Posterior pole photograph · 848 x 848 pixels · 45 degree fundus photograph — 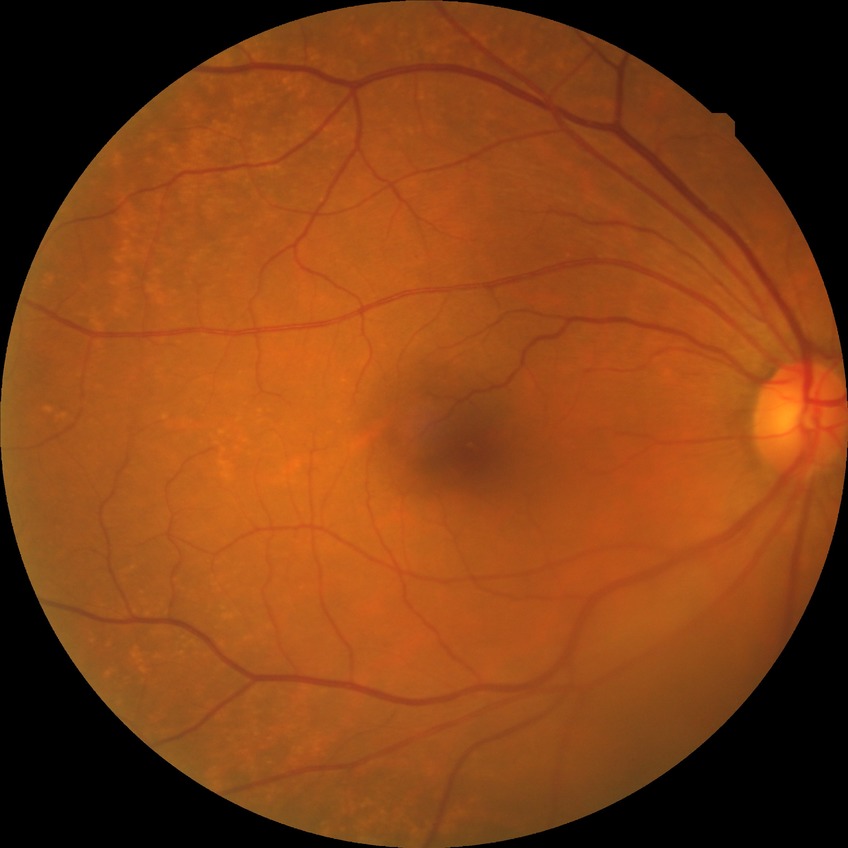

Davis stage: NDR. No diabetic retinal disease findings.